45-degree field of view; color fundus image; image size 1536x1152.
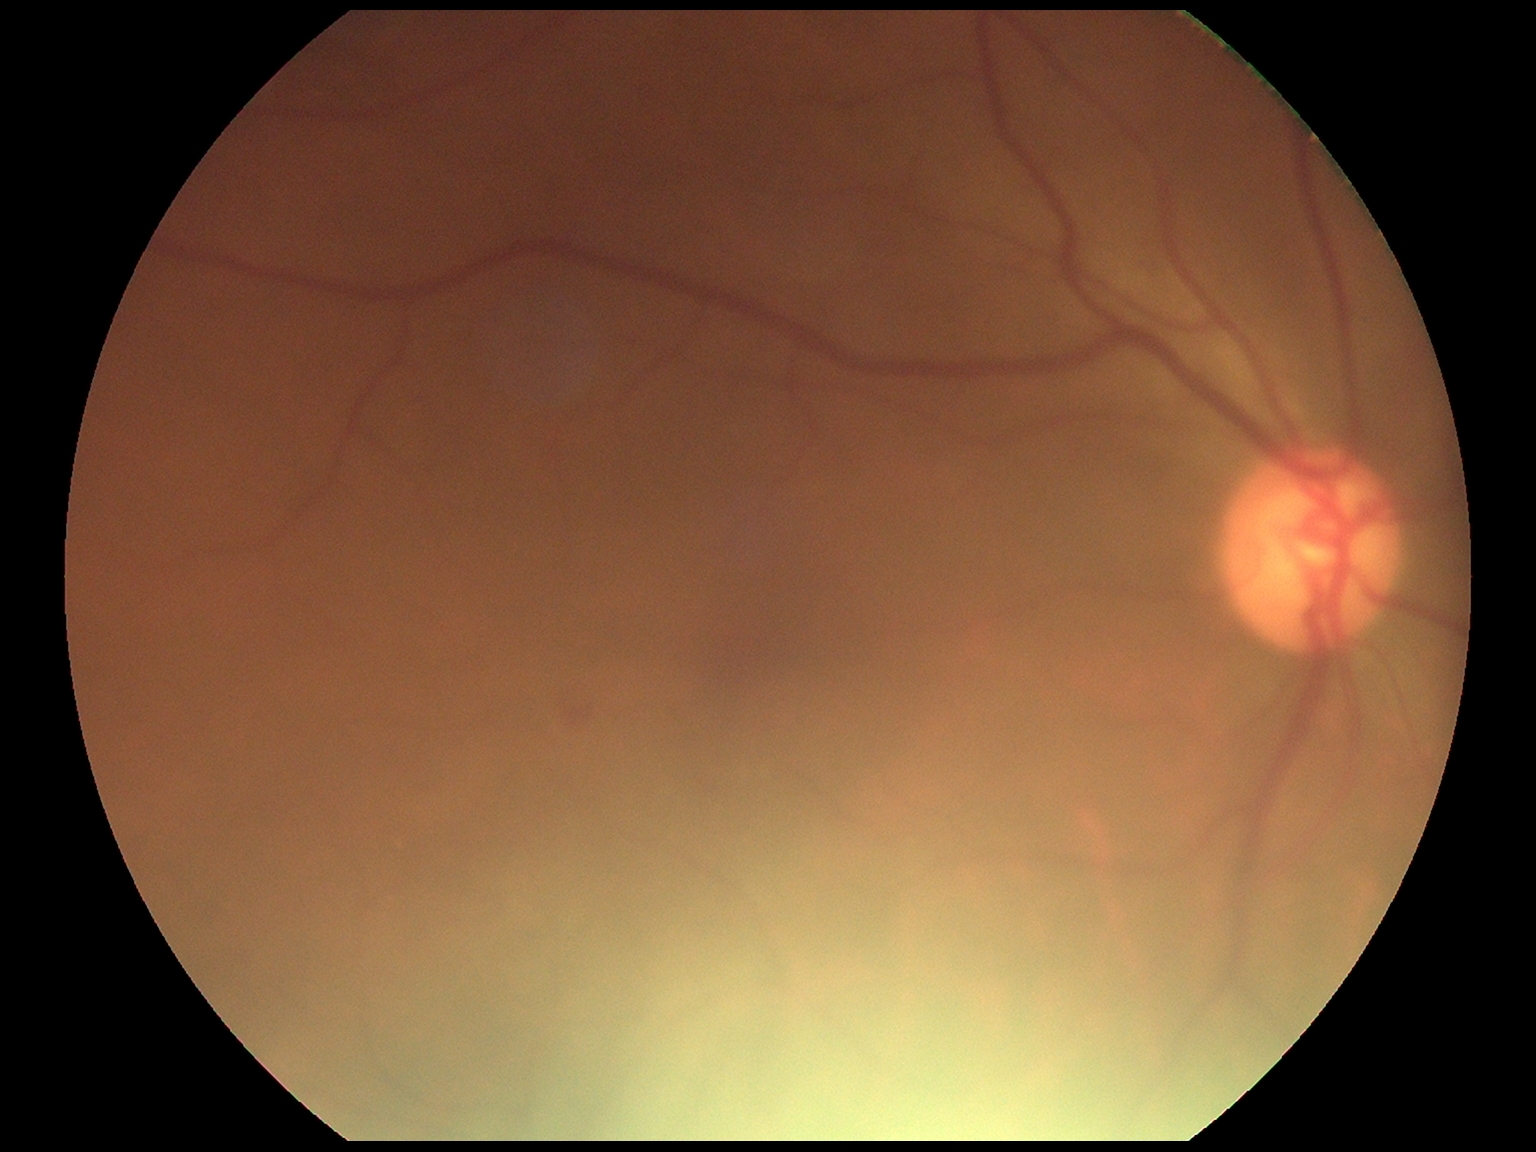
DR class: non-proliferative diabetic retinopathy. Retinopathy: moderate NPDR (grade 2).